Wide-field contact fundus photograph of an infant · camera: Clarity RetCam 3 (130° FOV):
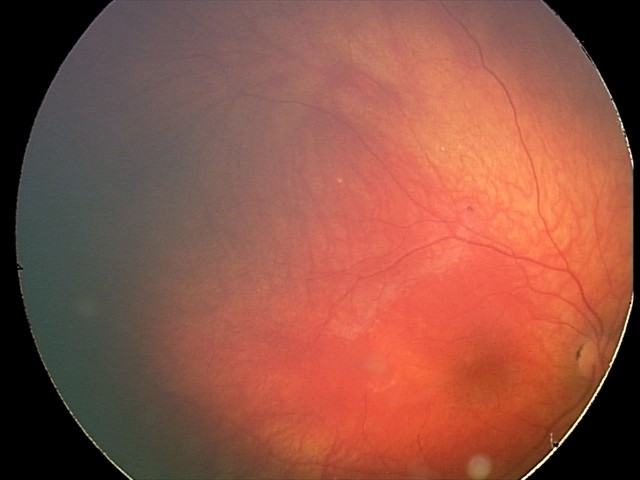 Series diagnosed as retinal astrocytic hamartoma.